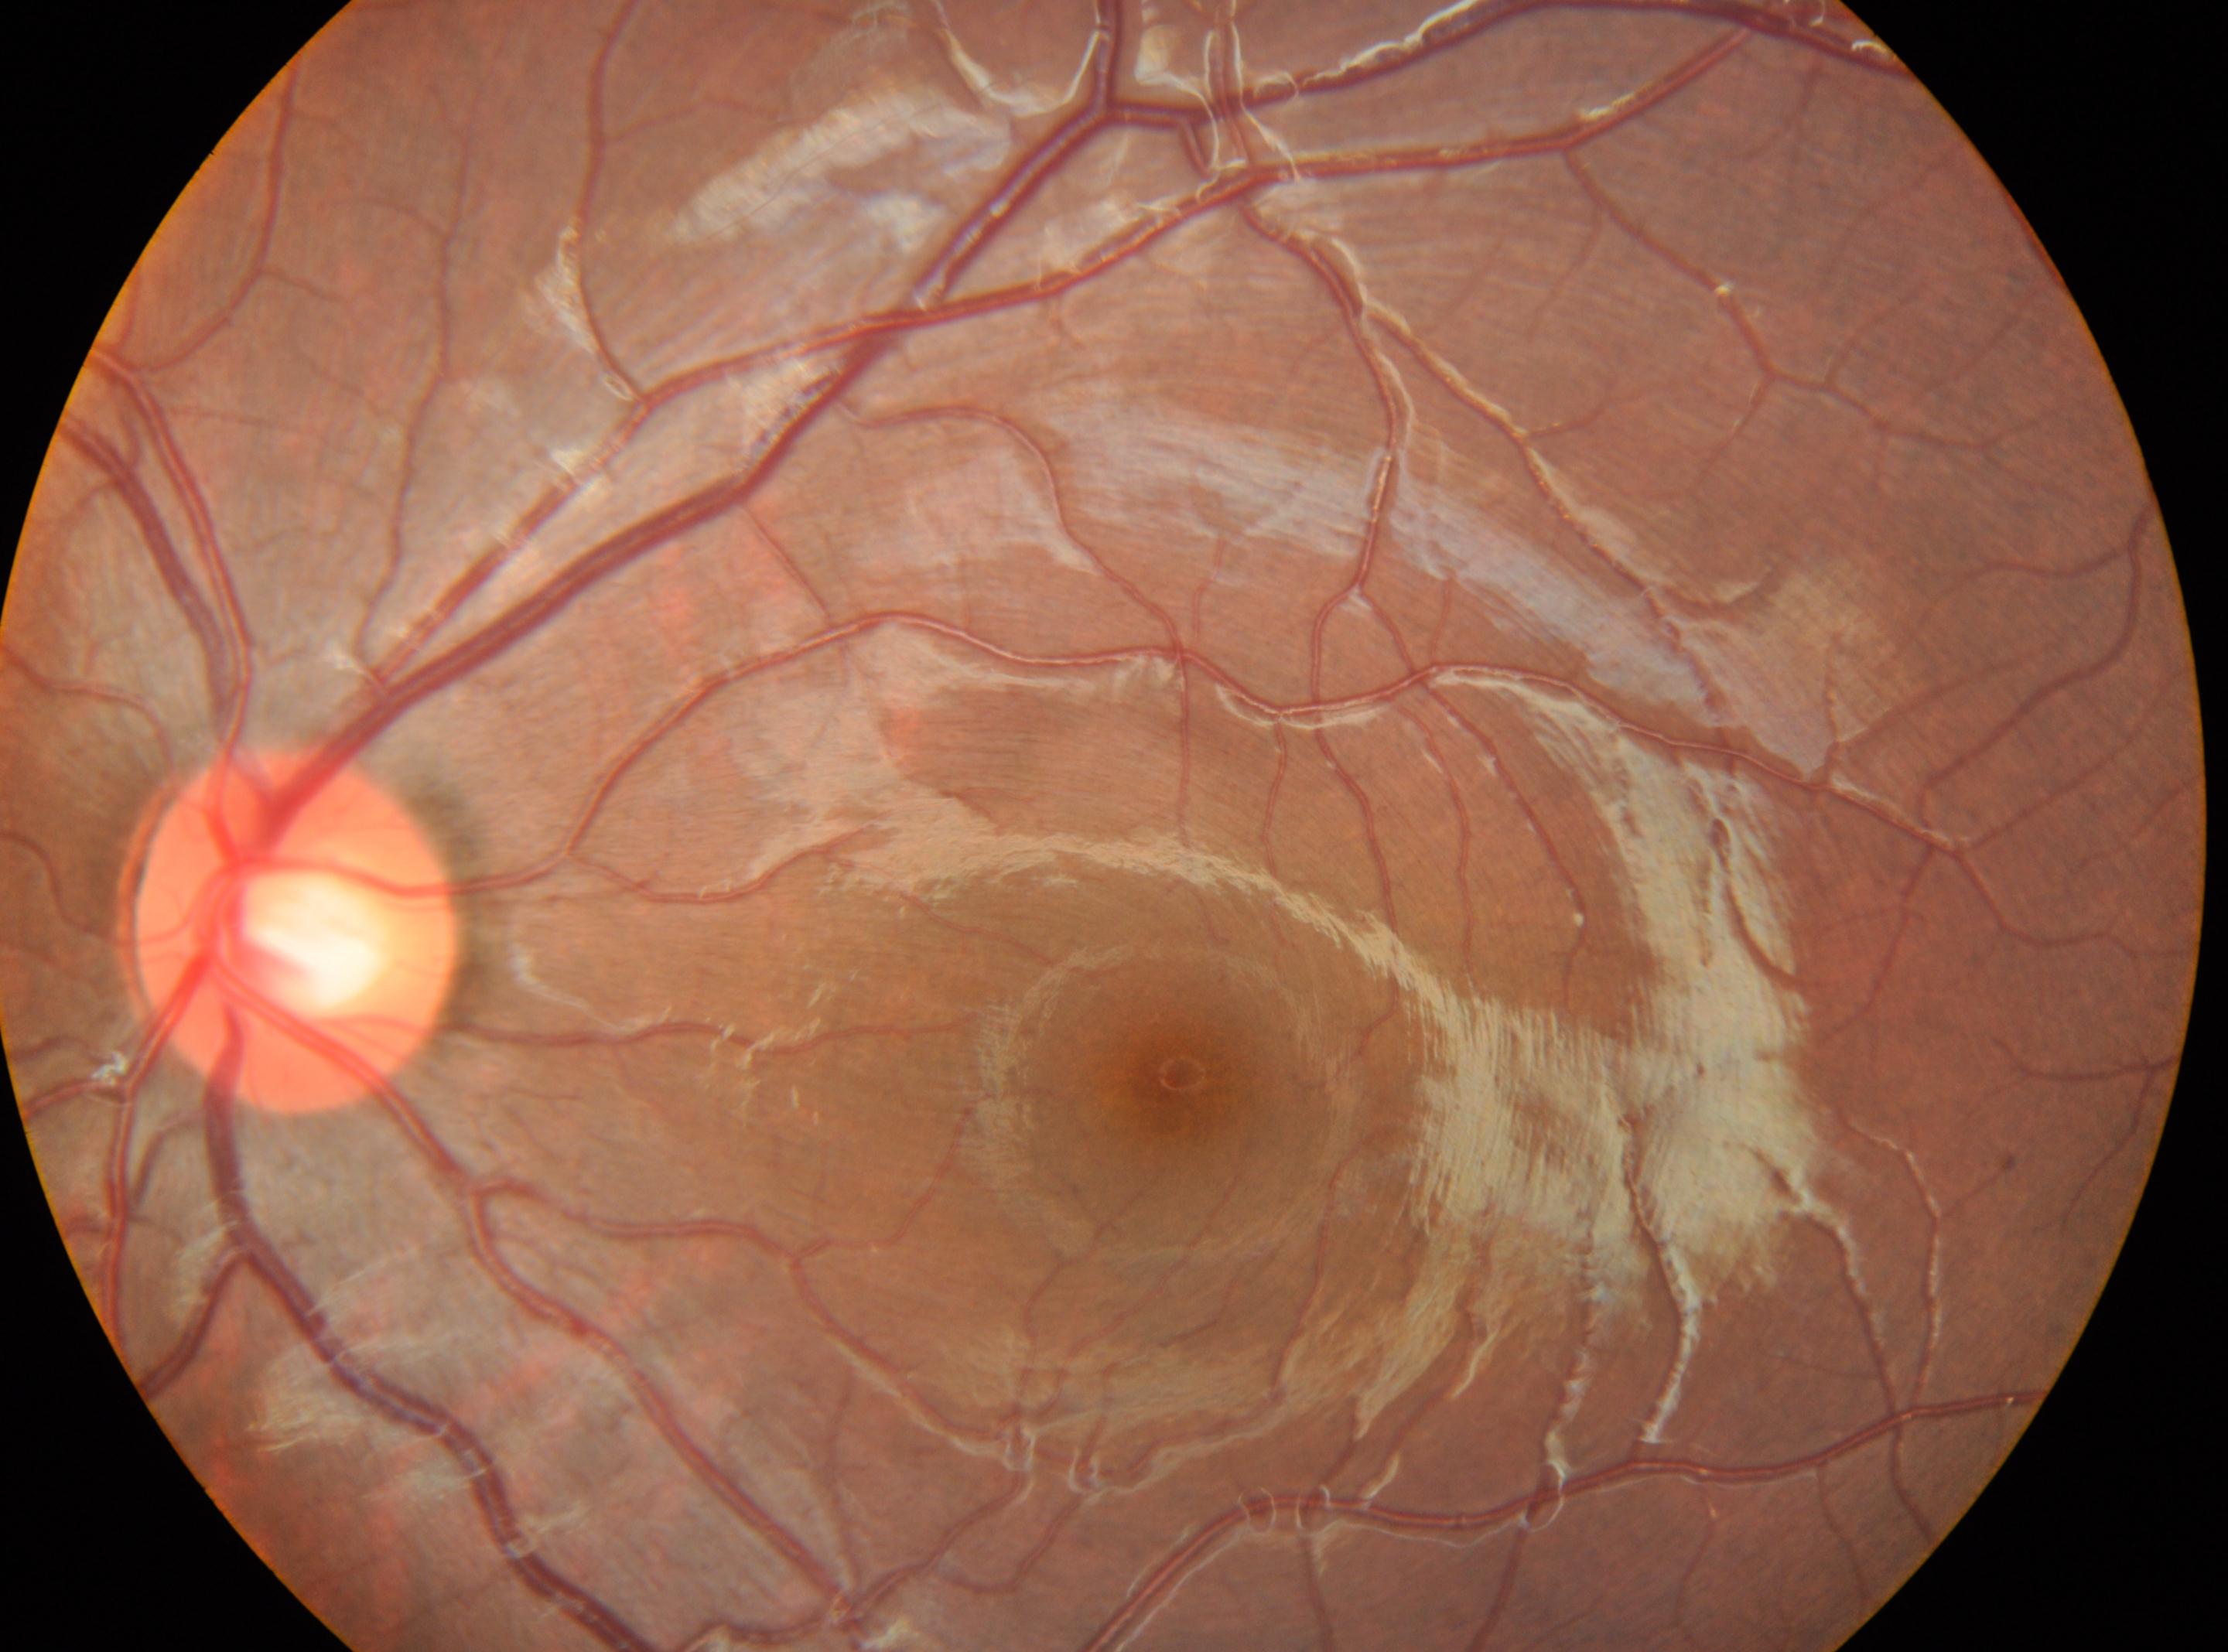
eye: OS, macula center: (x=1182, y=1072), DR: grade 0 (no apparent retinopathy), optic disc: (x=296, y=928).